Wide-field fundus photograph of an infant. Captured with the Clarity RetCam 3 (130° field of view). 640x480:
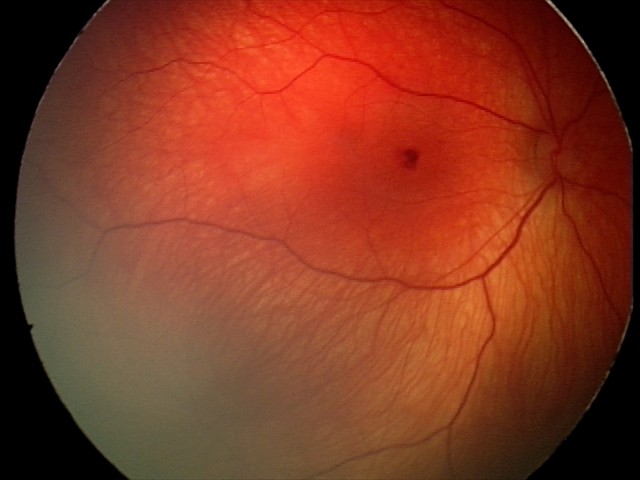 Finding: retinal hemorrhages.